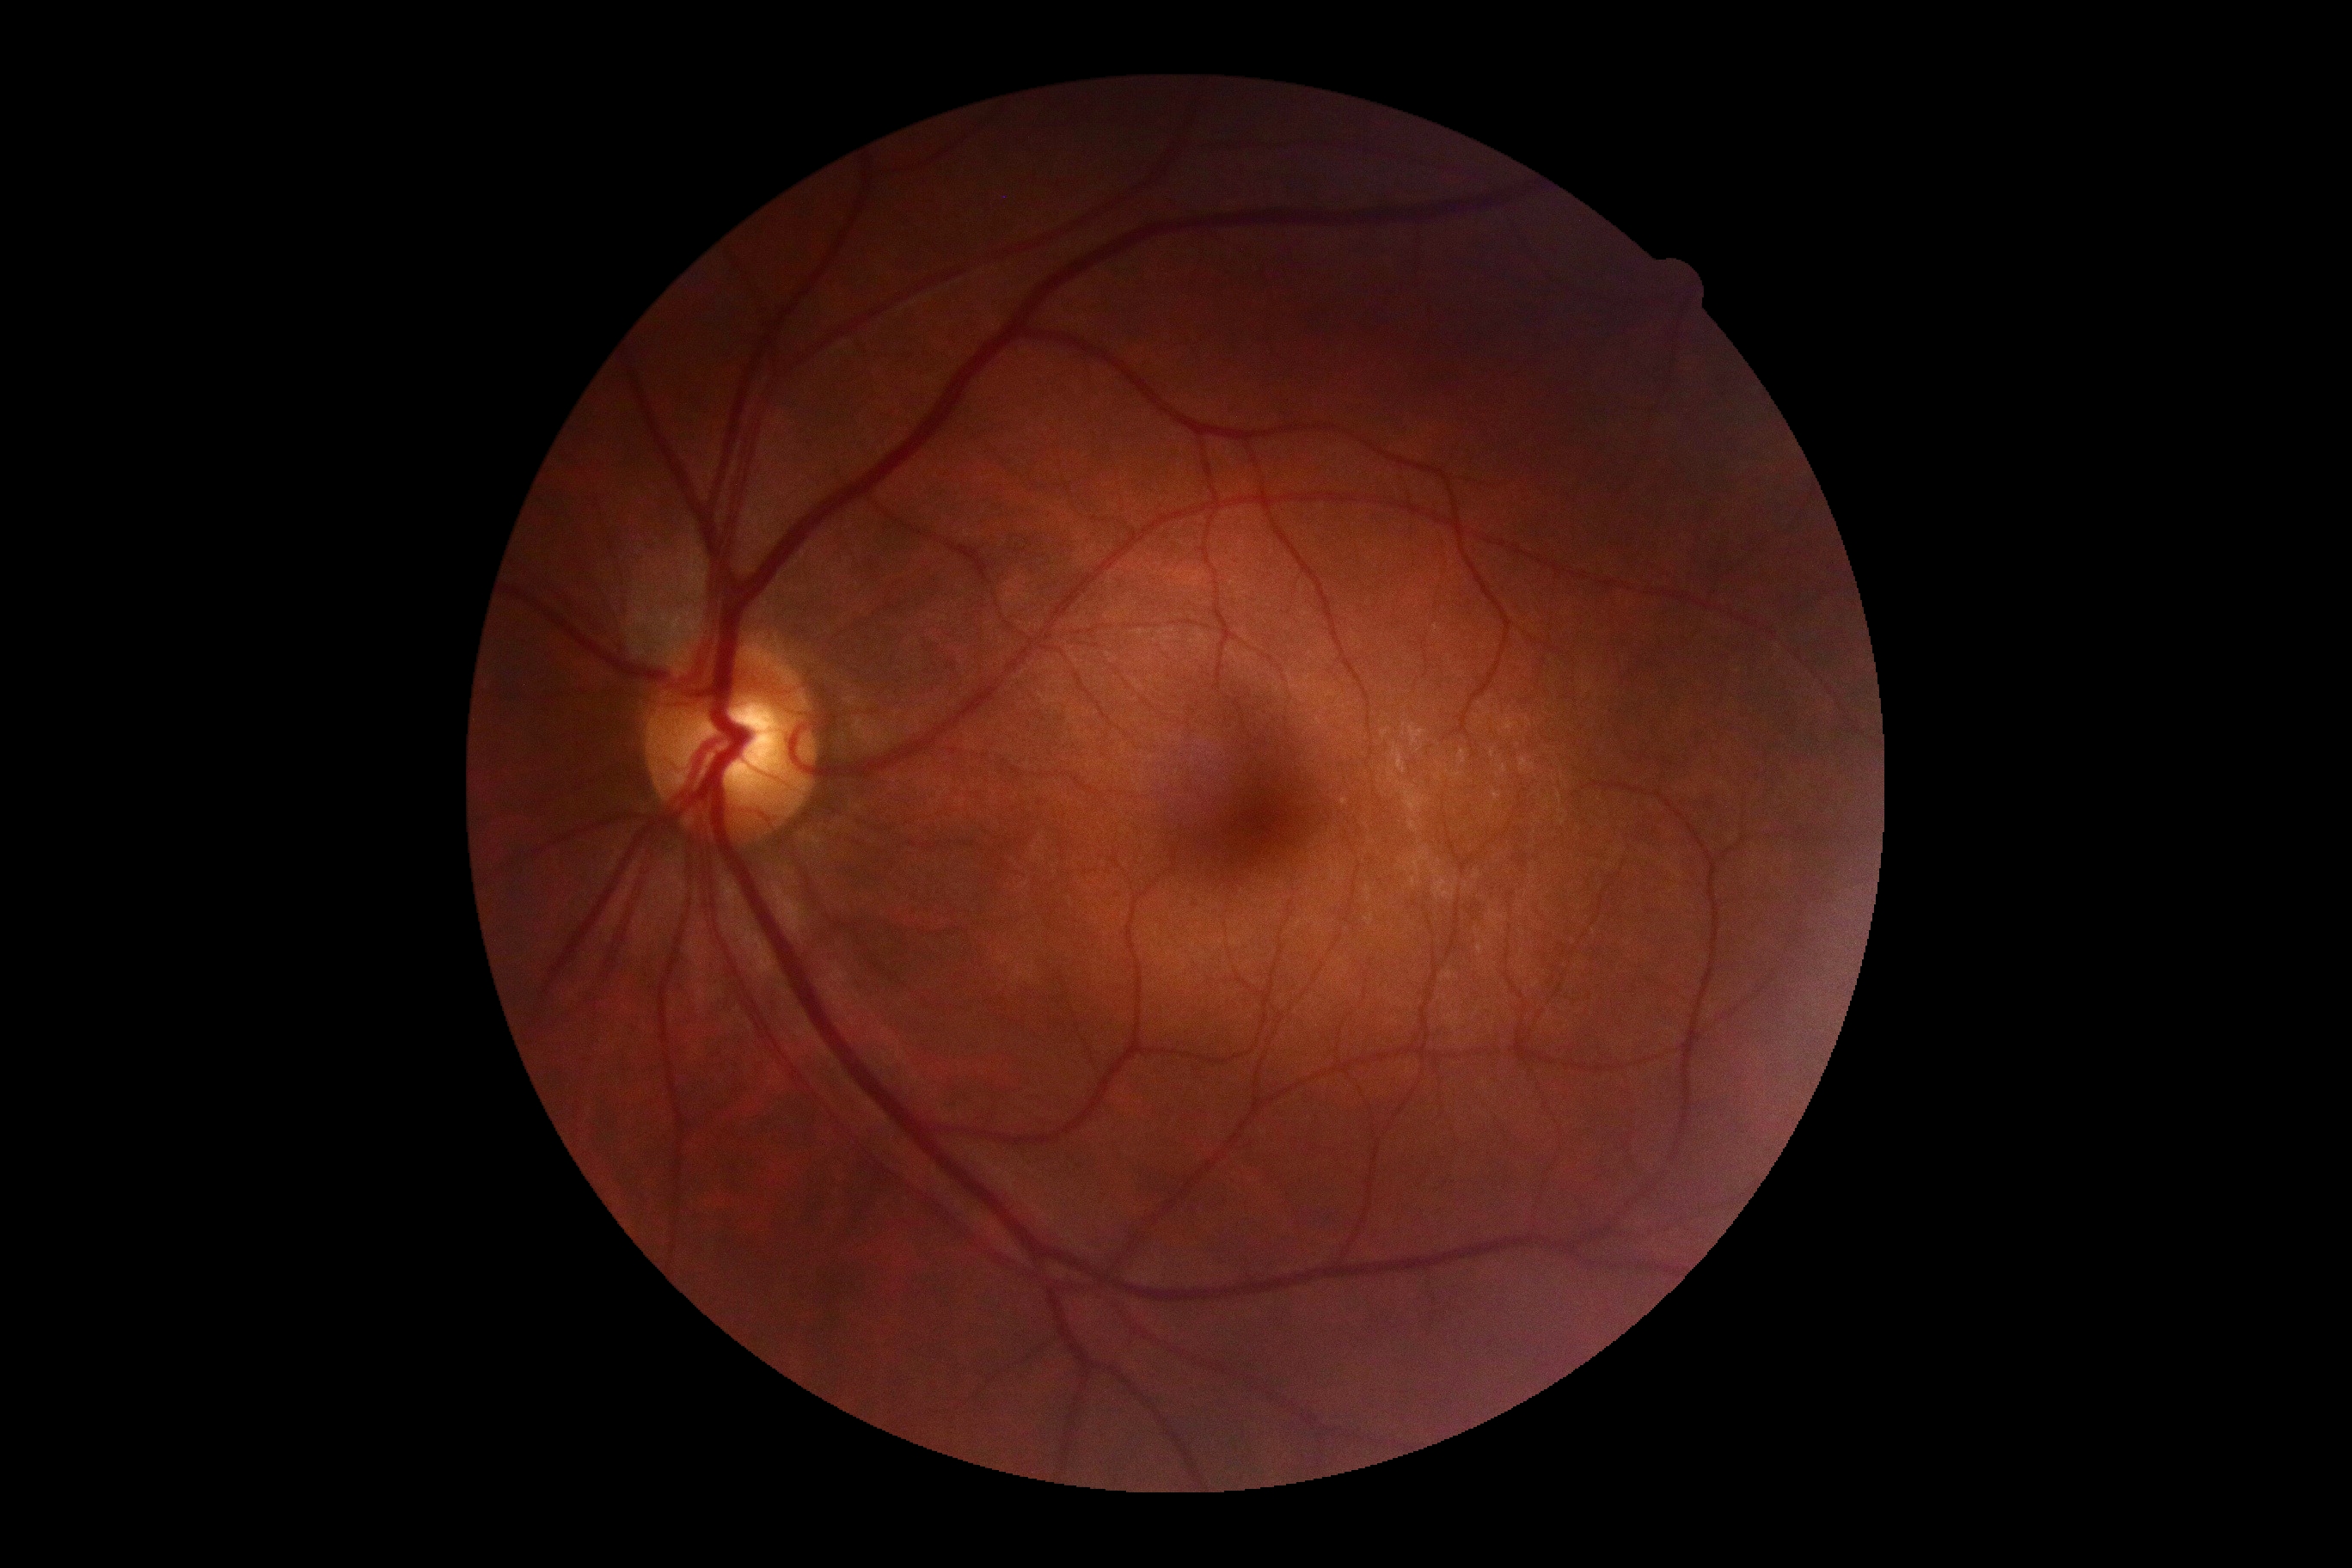 DR stage is grade 0 (no apparent retinopathy).
No DR findings.